Image size 2048x1536; CFP — 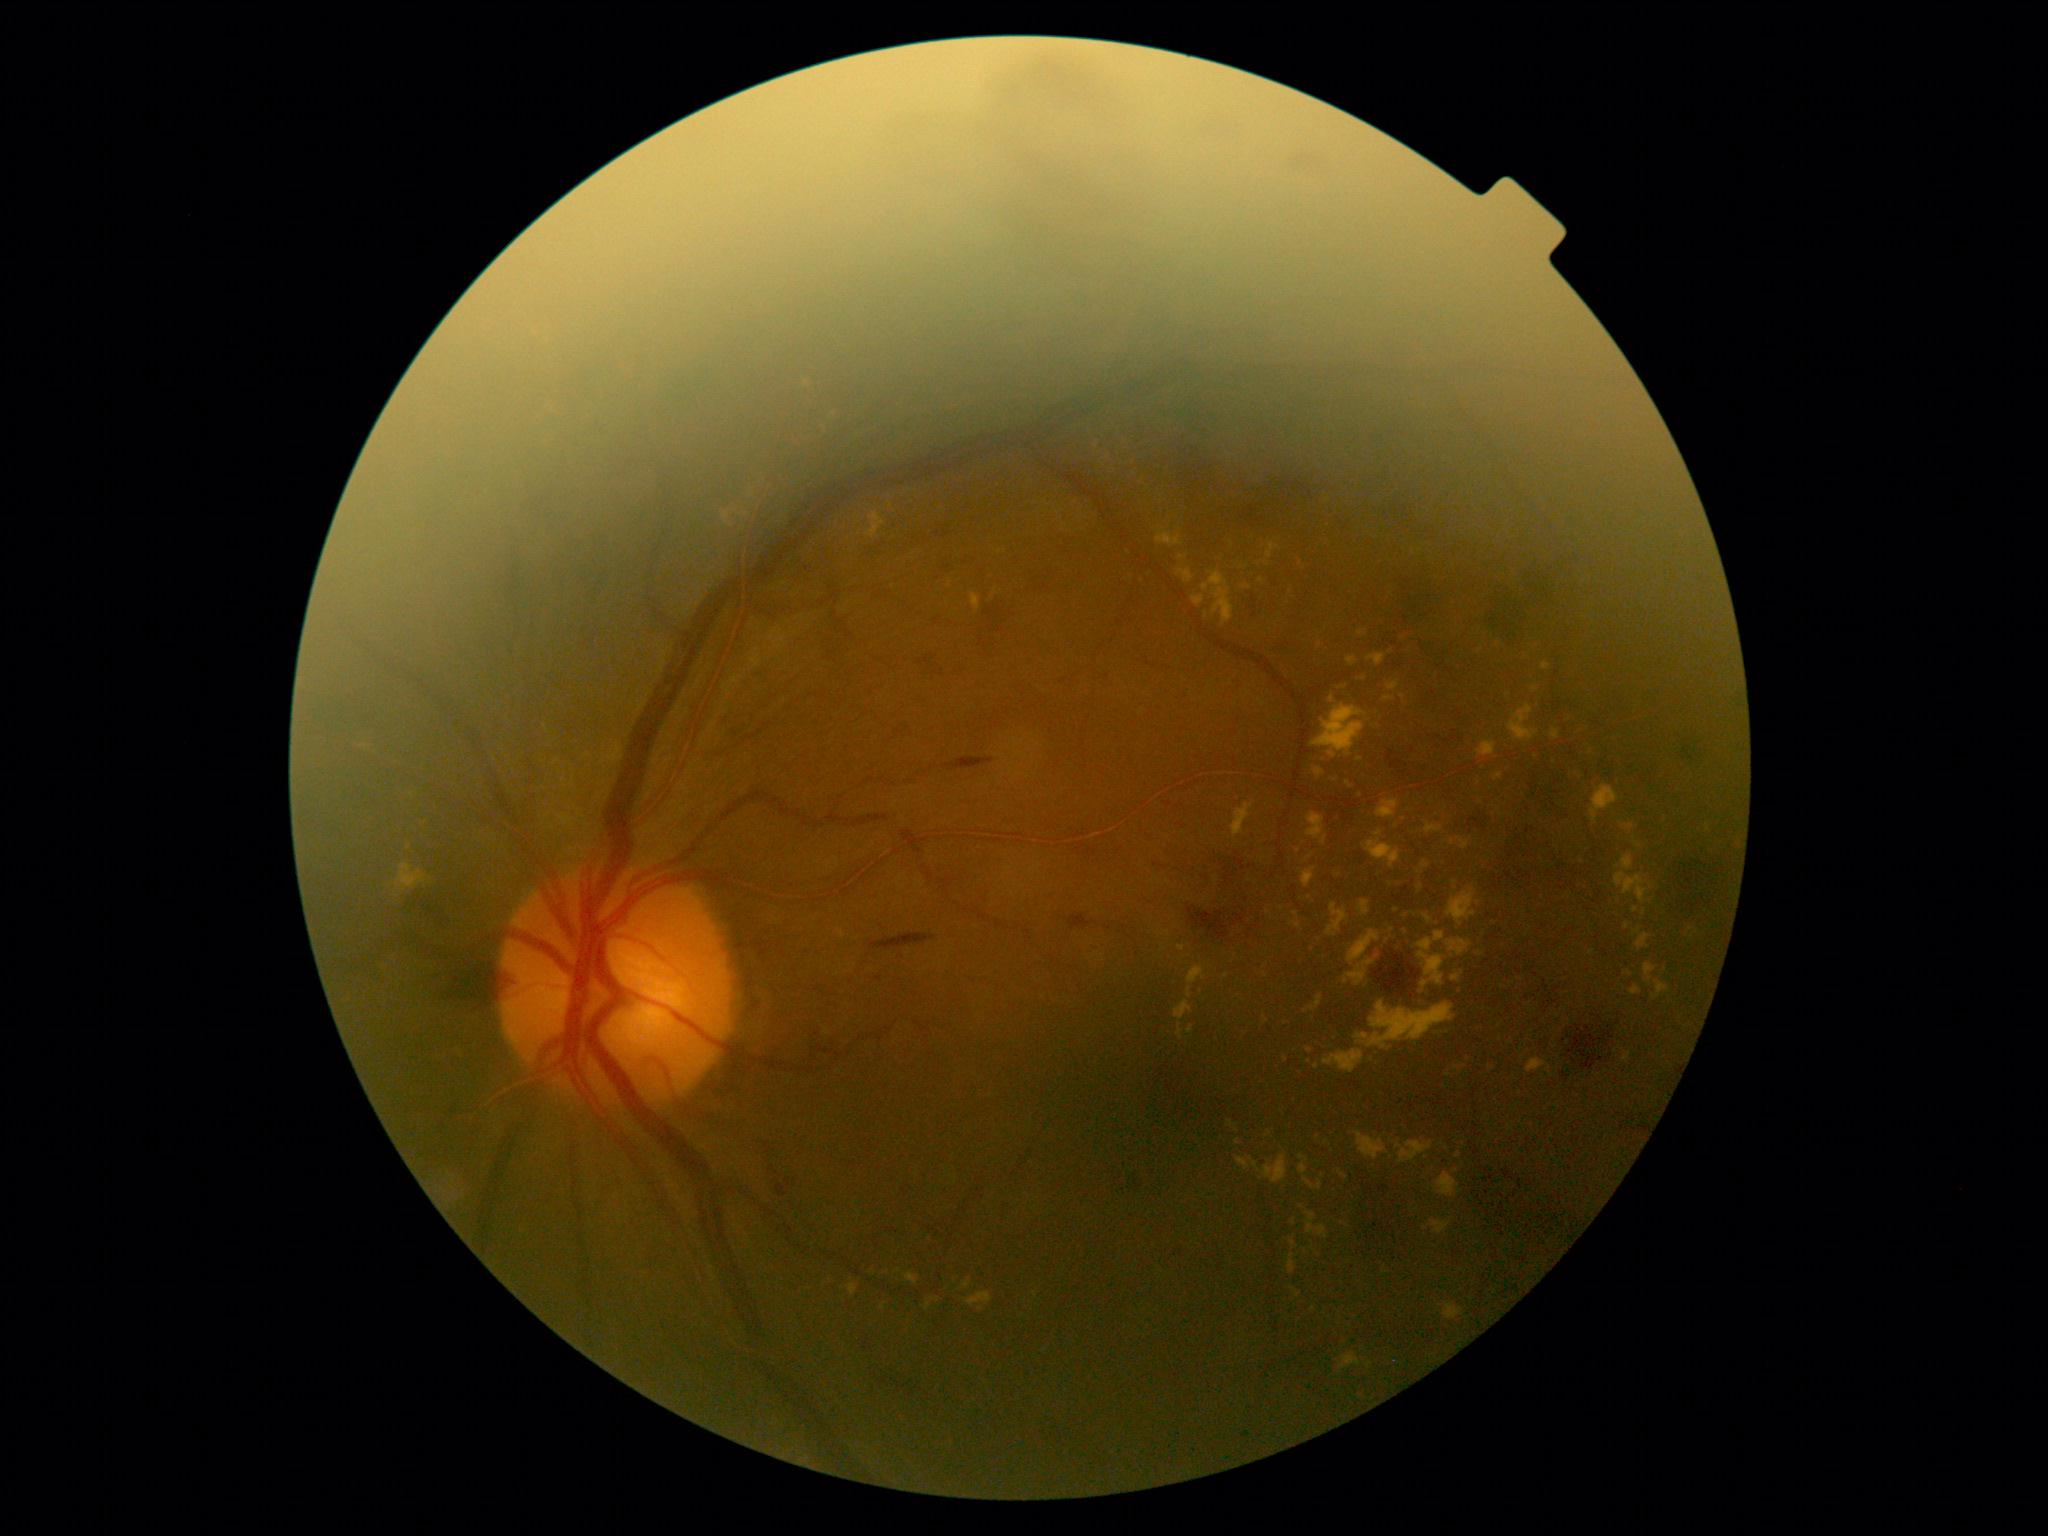

Diabetic retinopathy severity is moderate NPDR (grade 2). DR class: non-proliferative diabetic retinopathy.